Graded on the modified Davis scale. NIDEK AFC-230 fundus camera
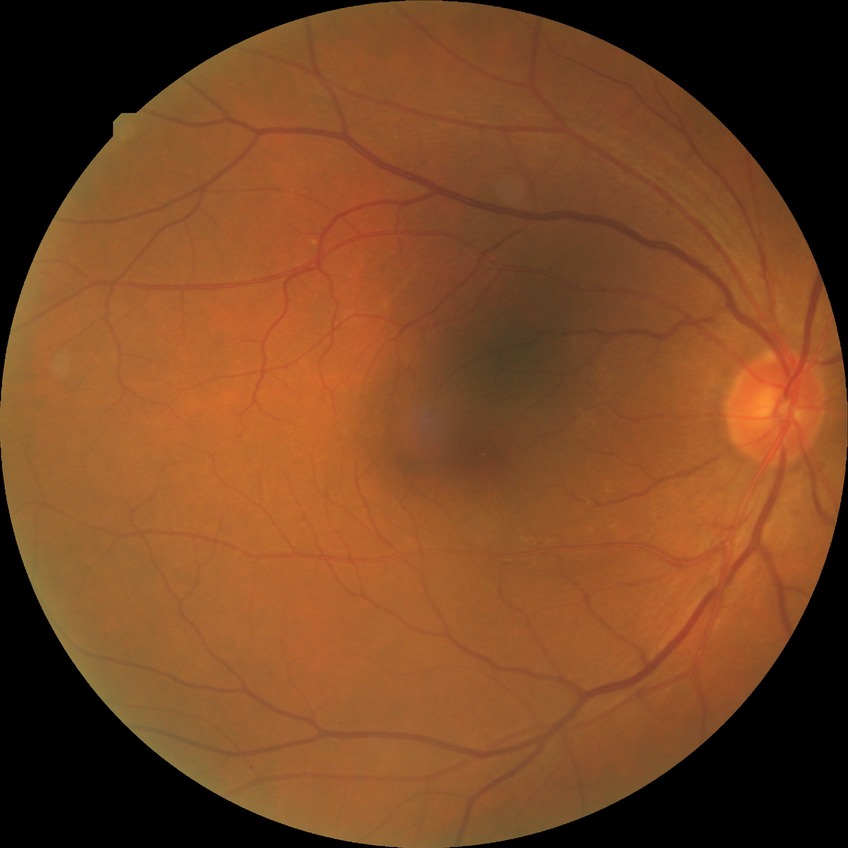
Diabetic retinopathy (DR): no diabetic retinopathy (NDR).